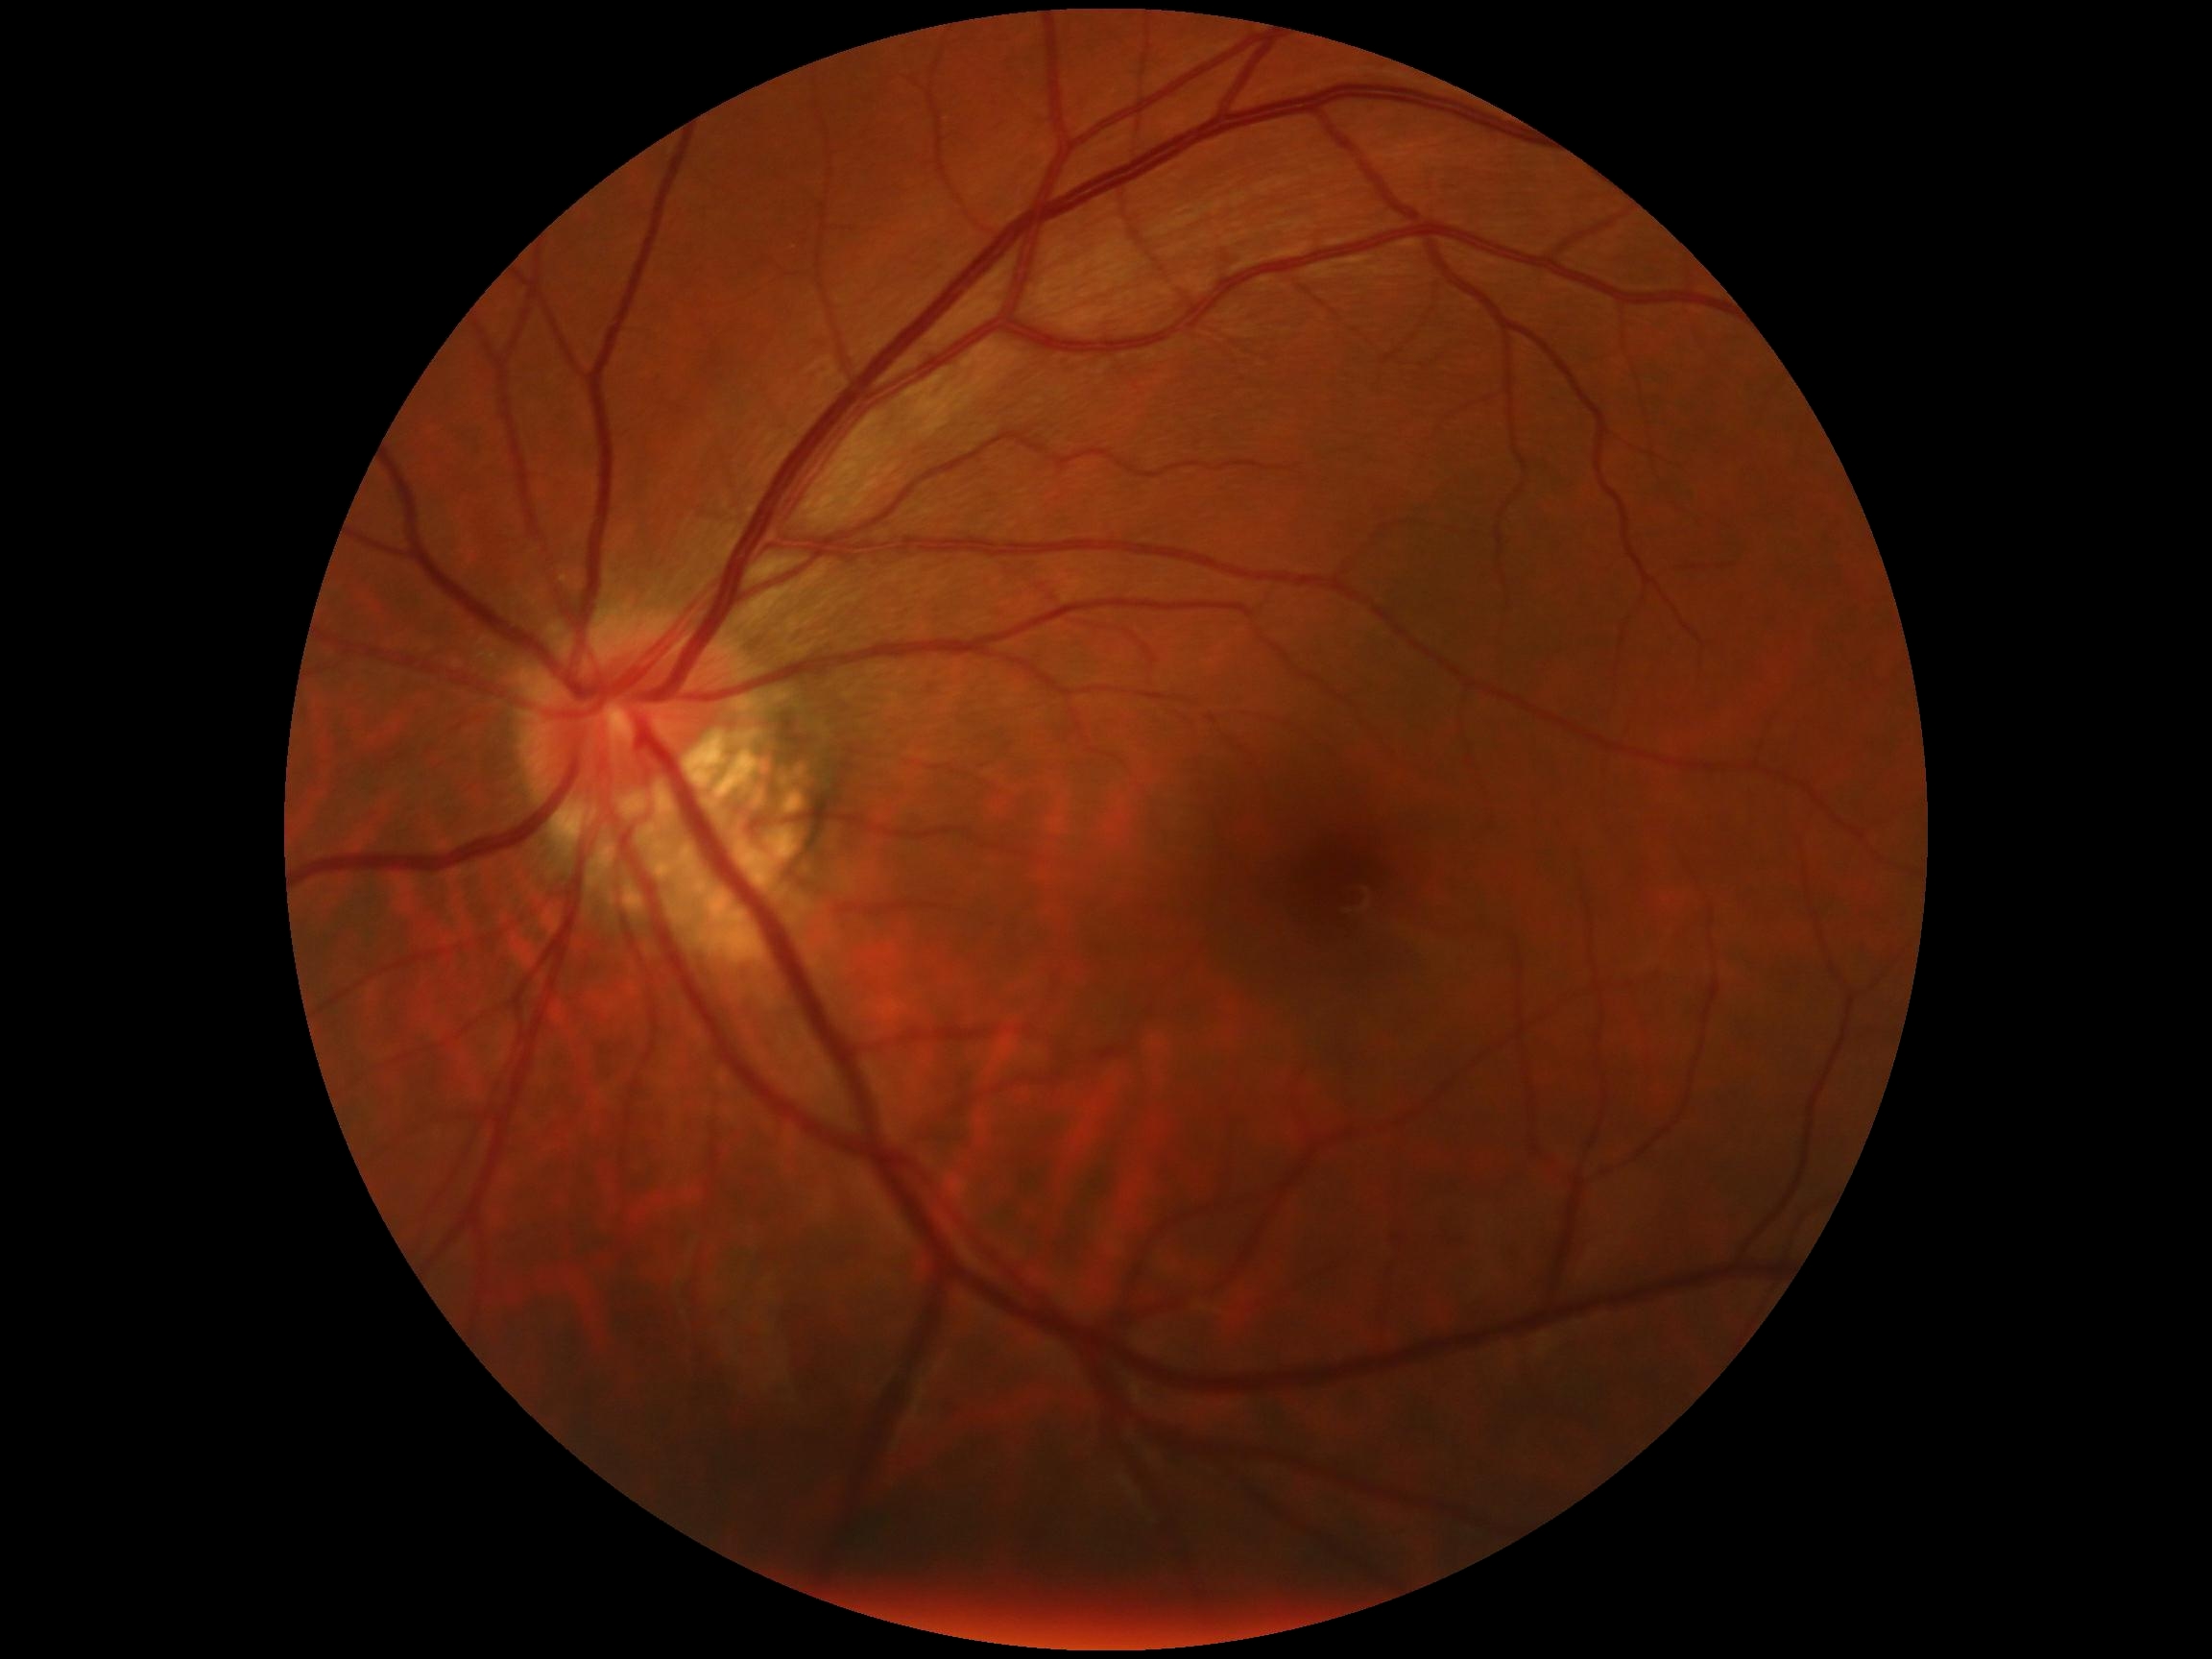
Diabetic retinopathy grade is 0 (no apparent retinopathy) — no visible signs of diabetic retinopathy.